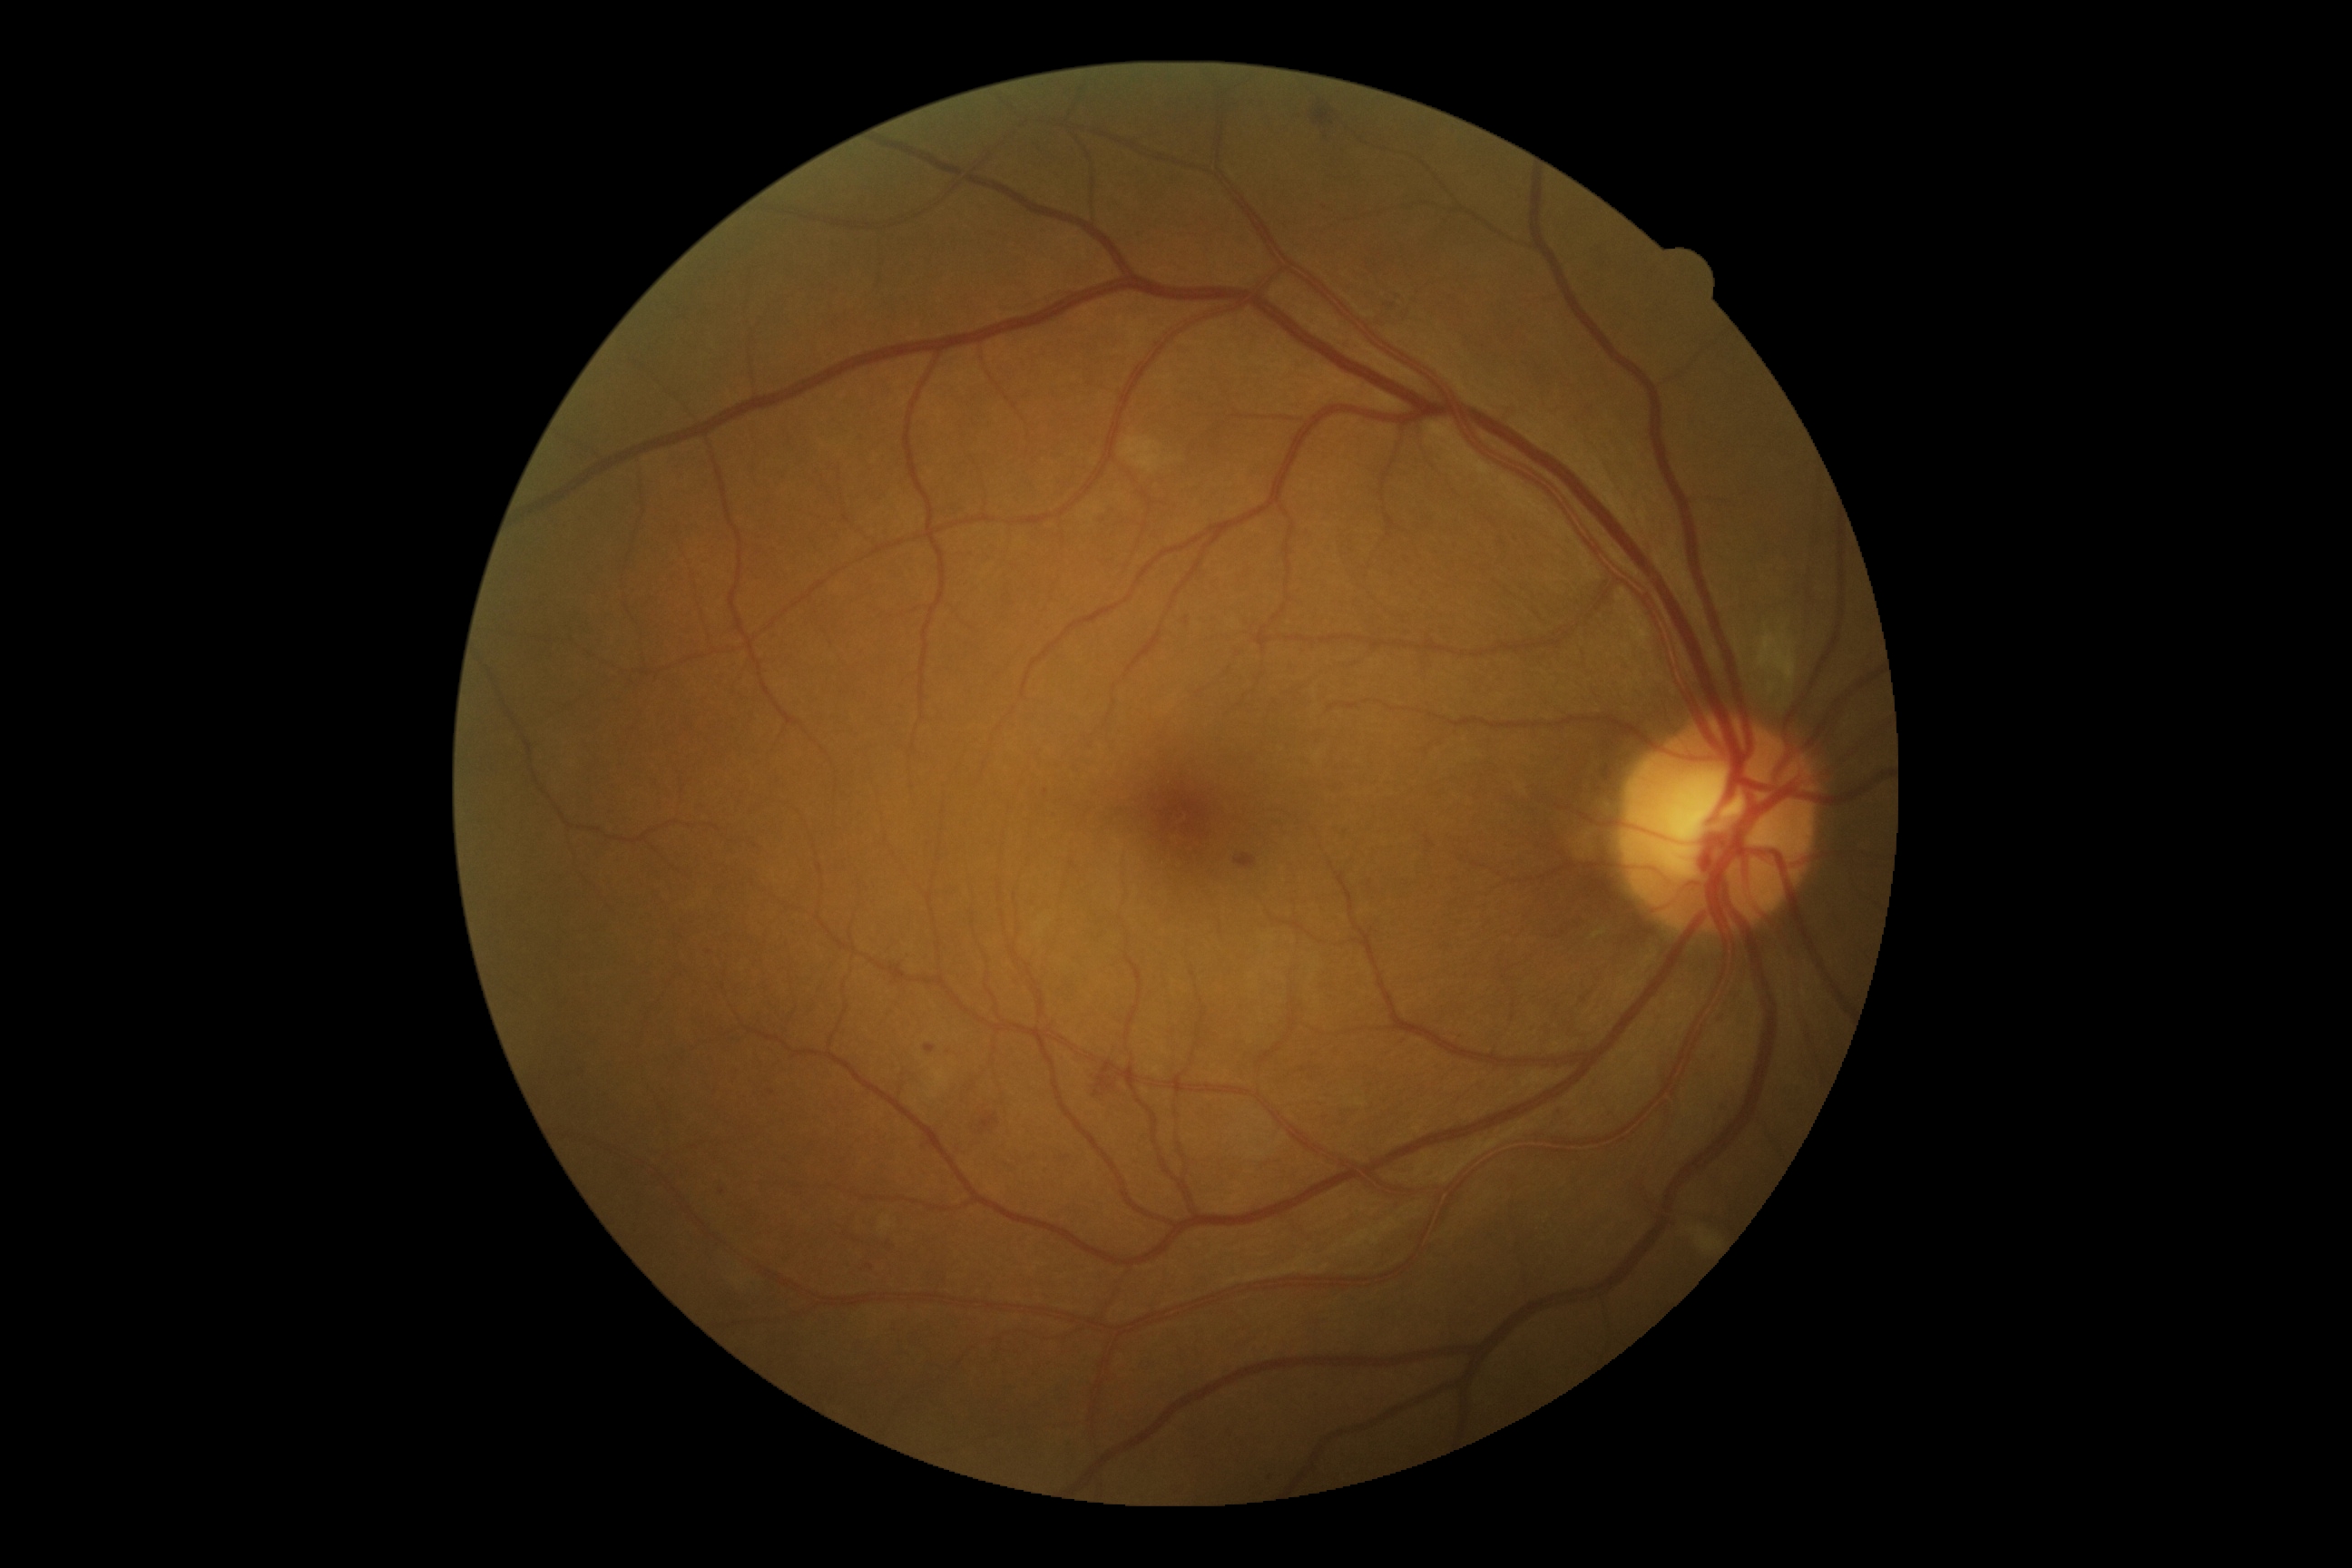
{
  "dr_grade": "moderate non-proliferative diabetic retinopathy (grade 2)"
}